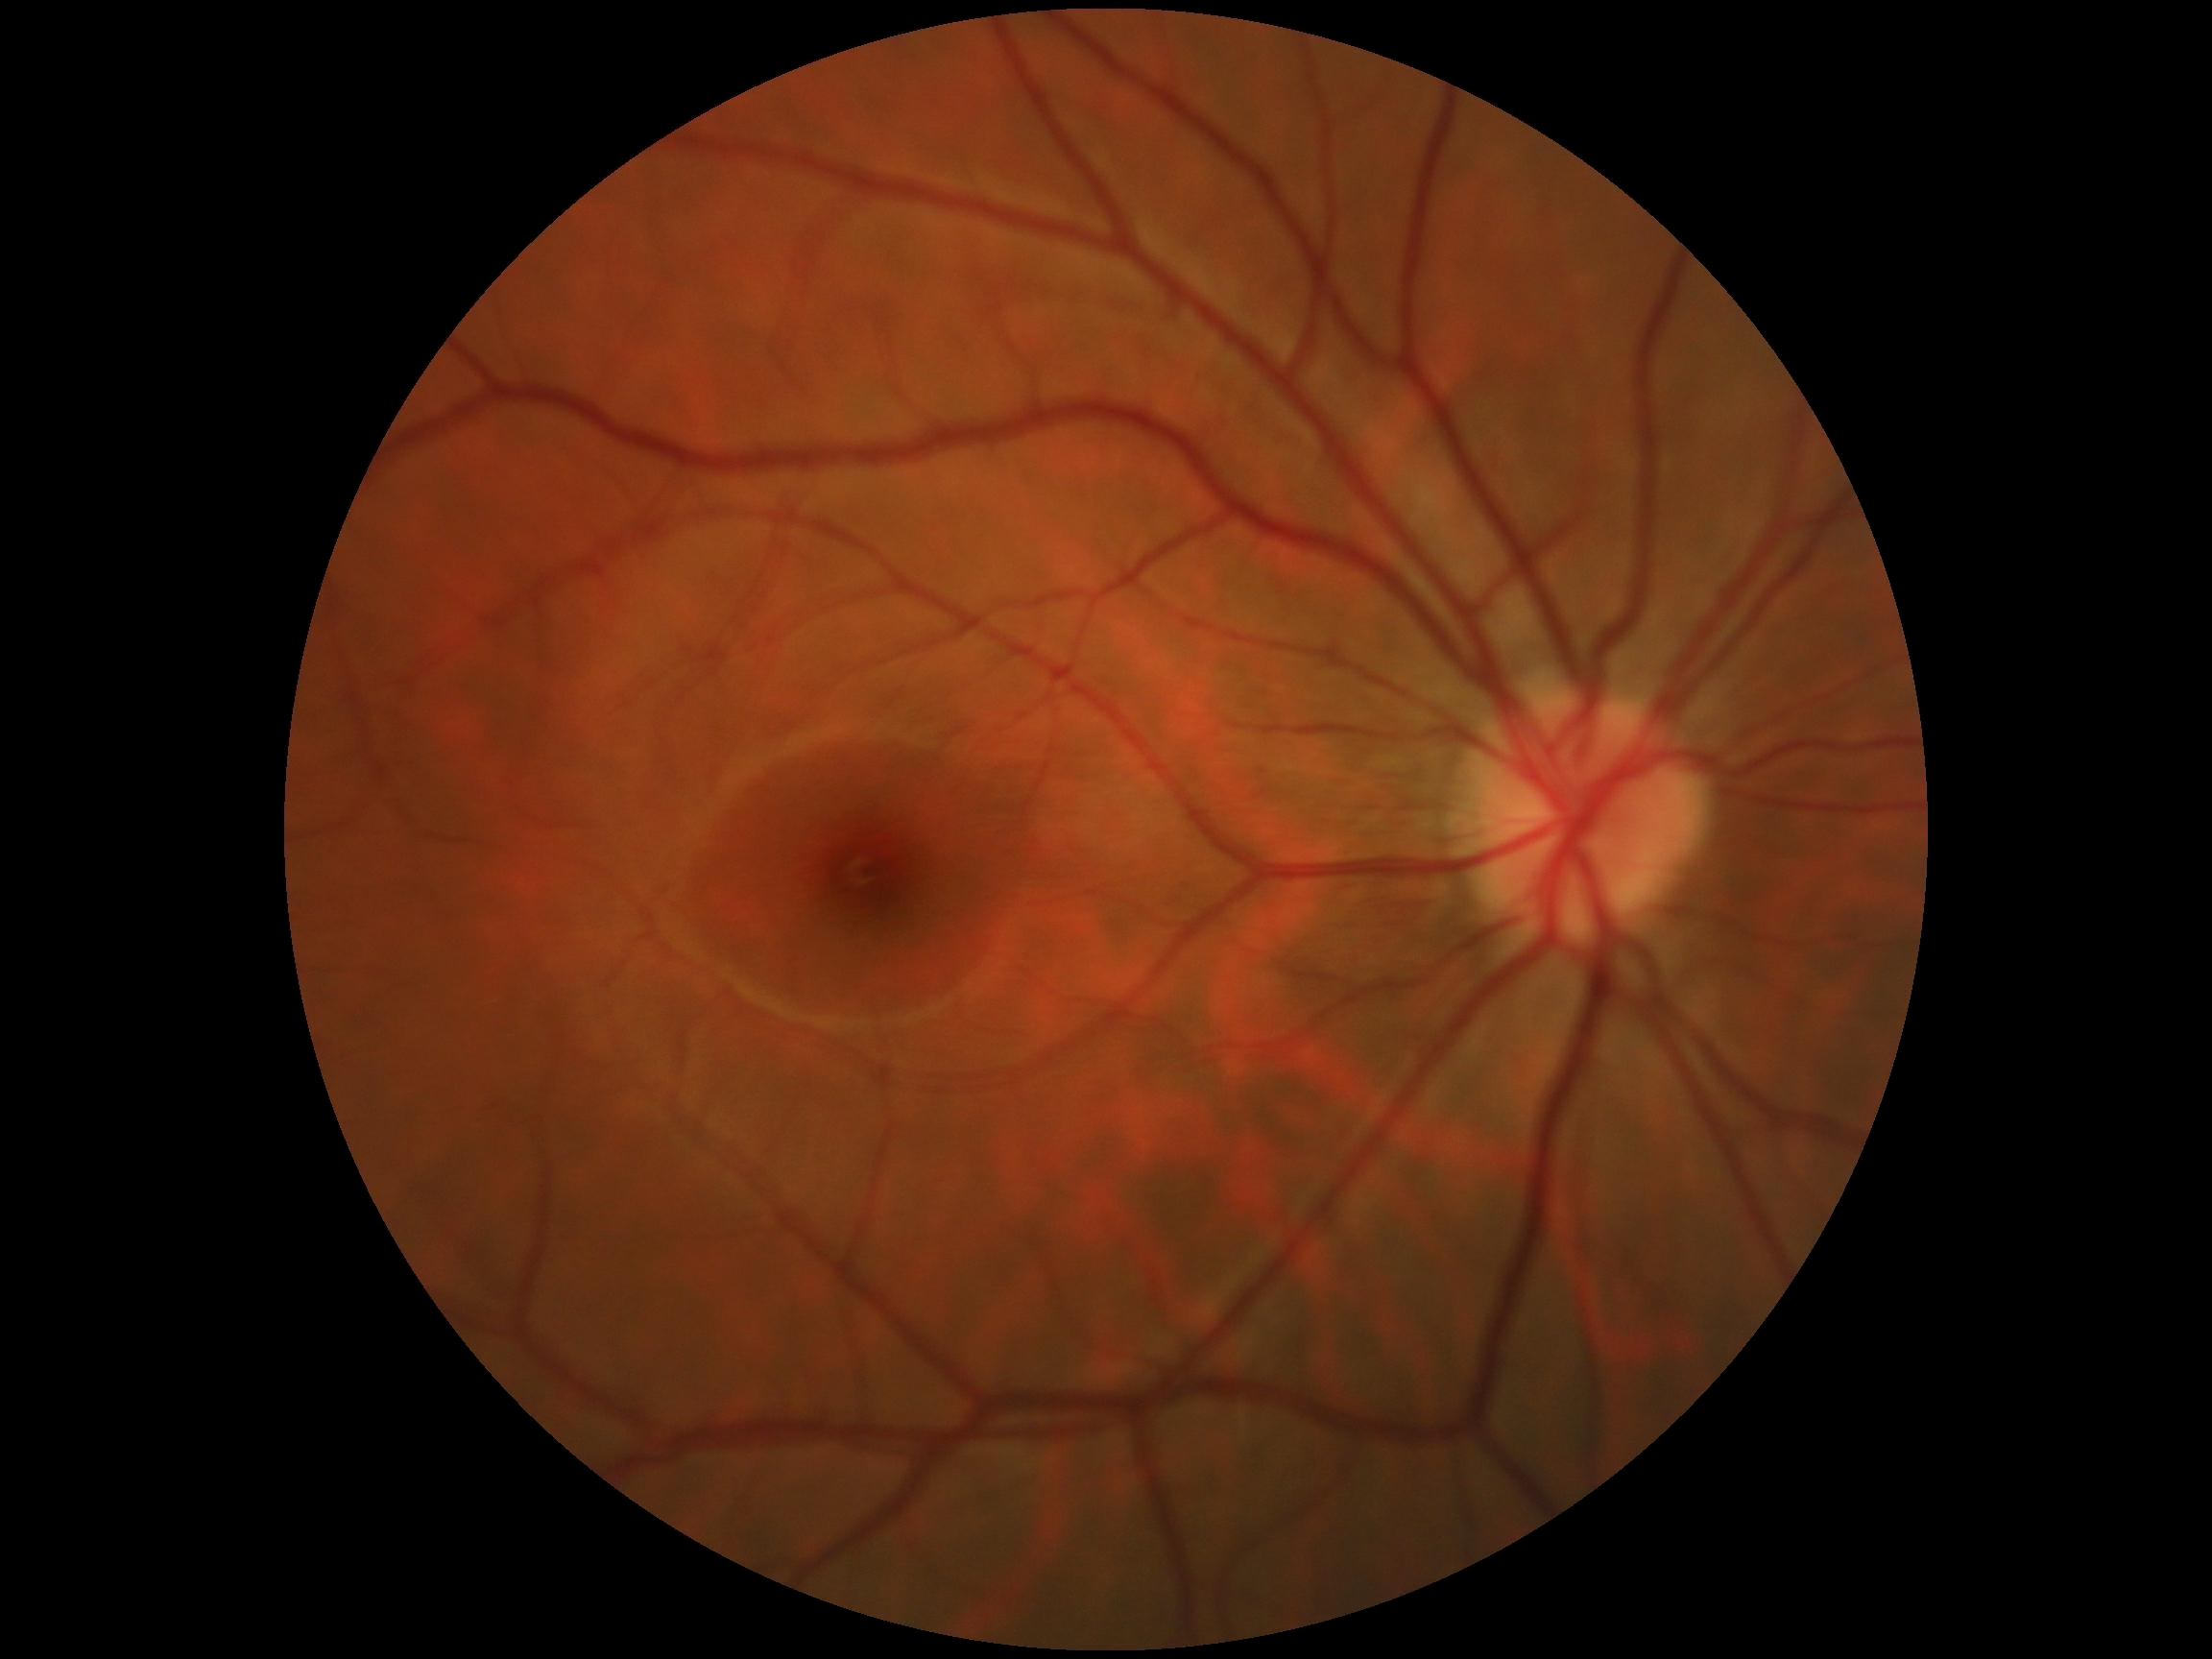
DR severity: grade 0.